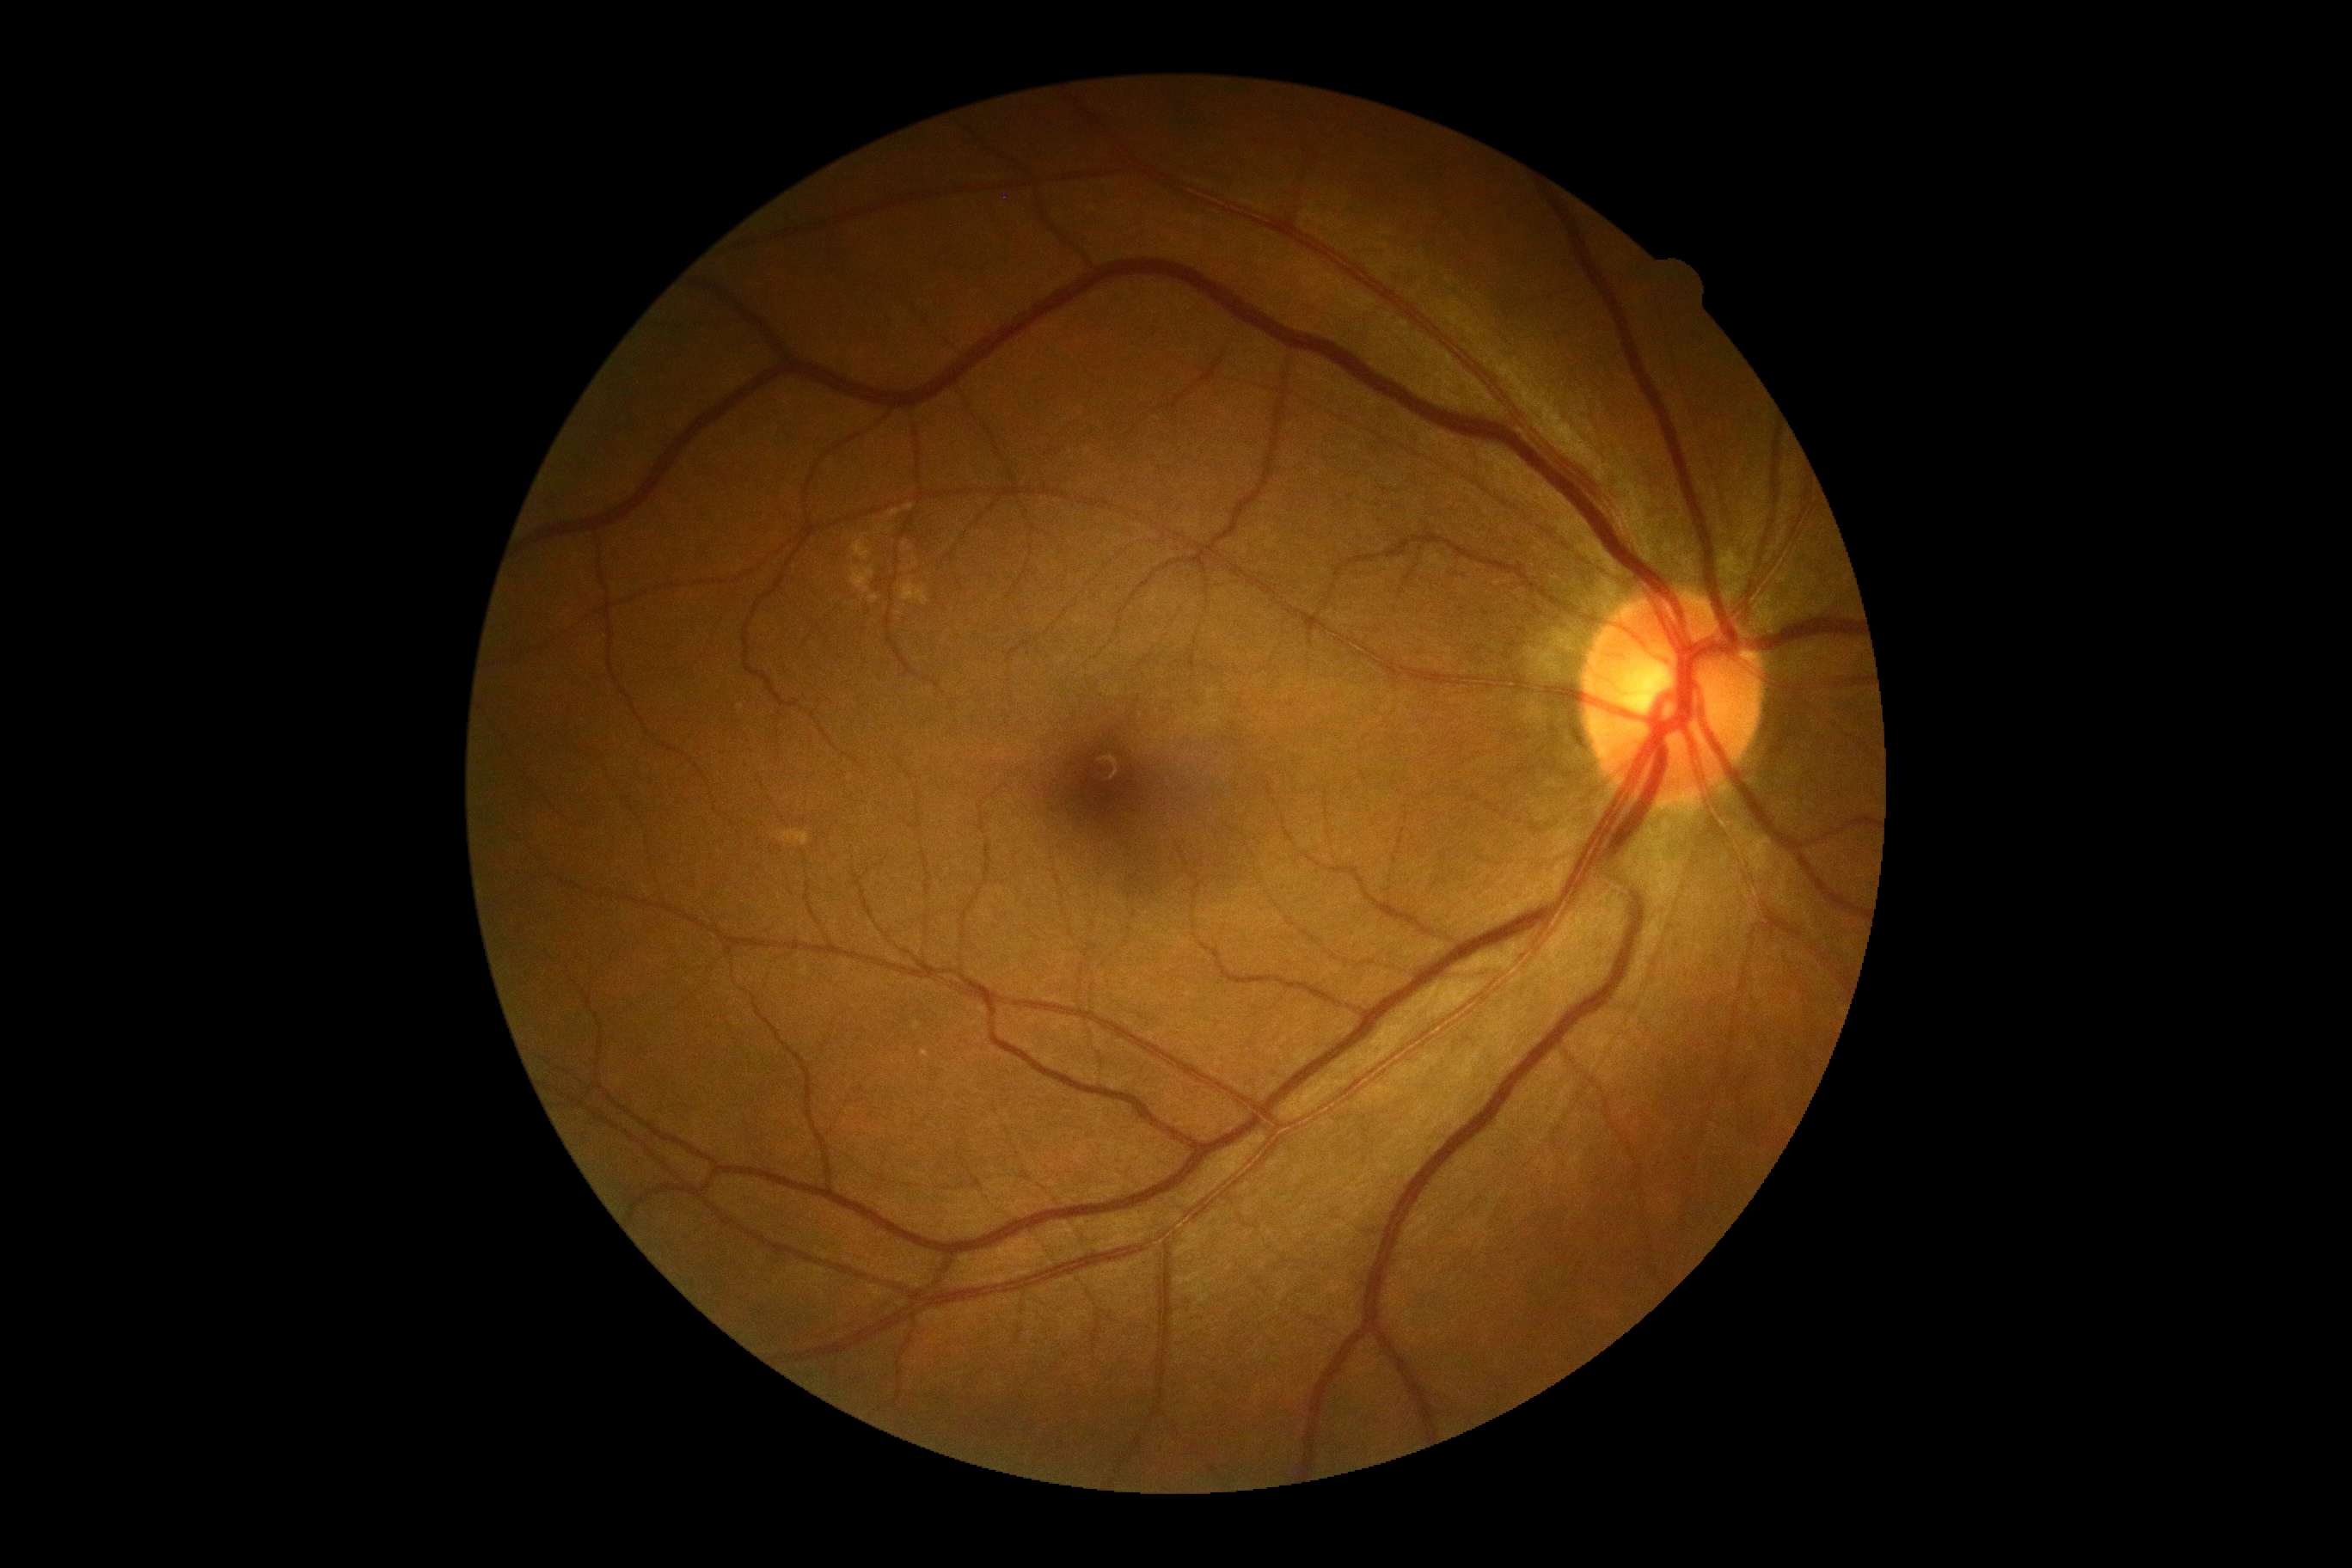 No signs of diabetic retinopathy. DR stage is no apparent diabetic retinopathy (grade 0).